45 degree fundus photograph. Image size 848x848. NIDEK AFC-230 — 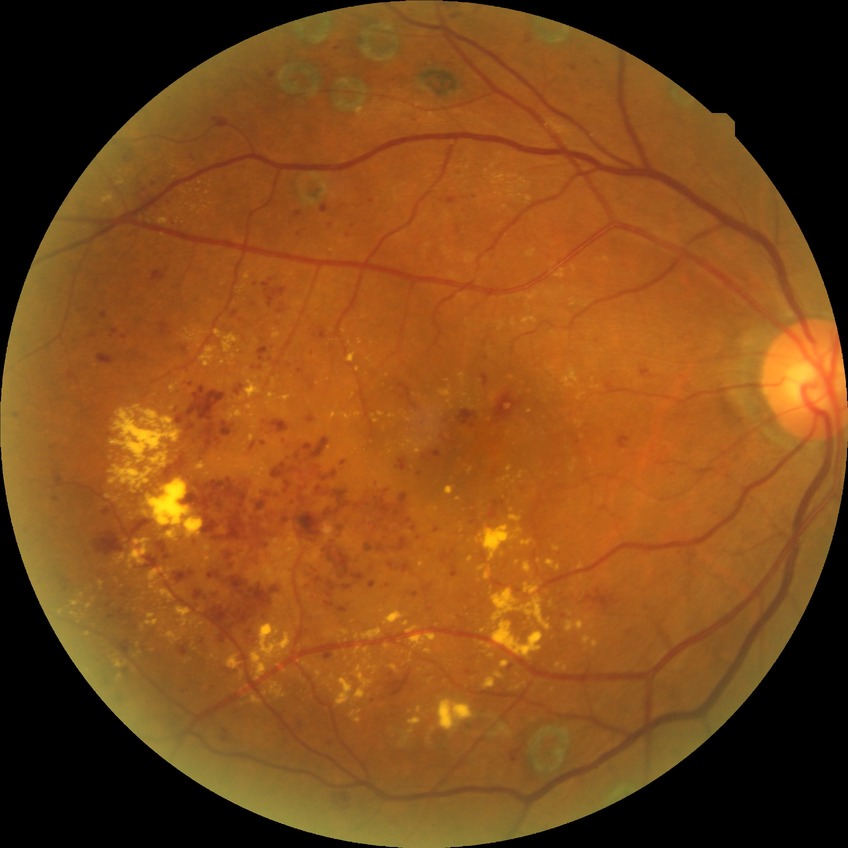 retinopathy stage: proliferative diabetic retinopathy.